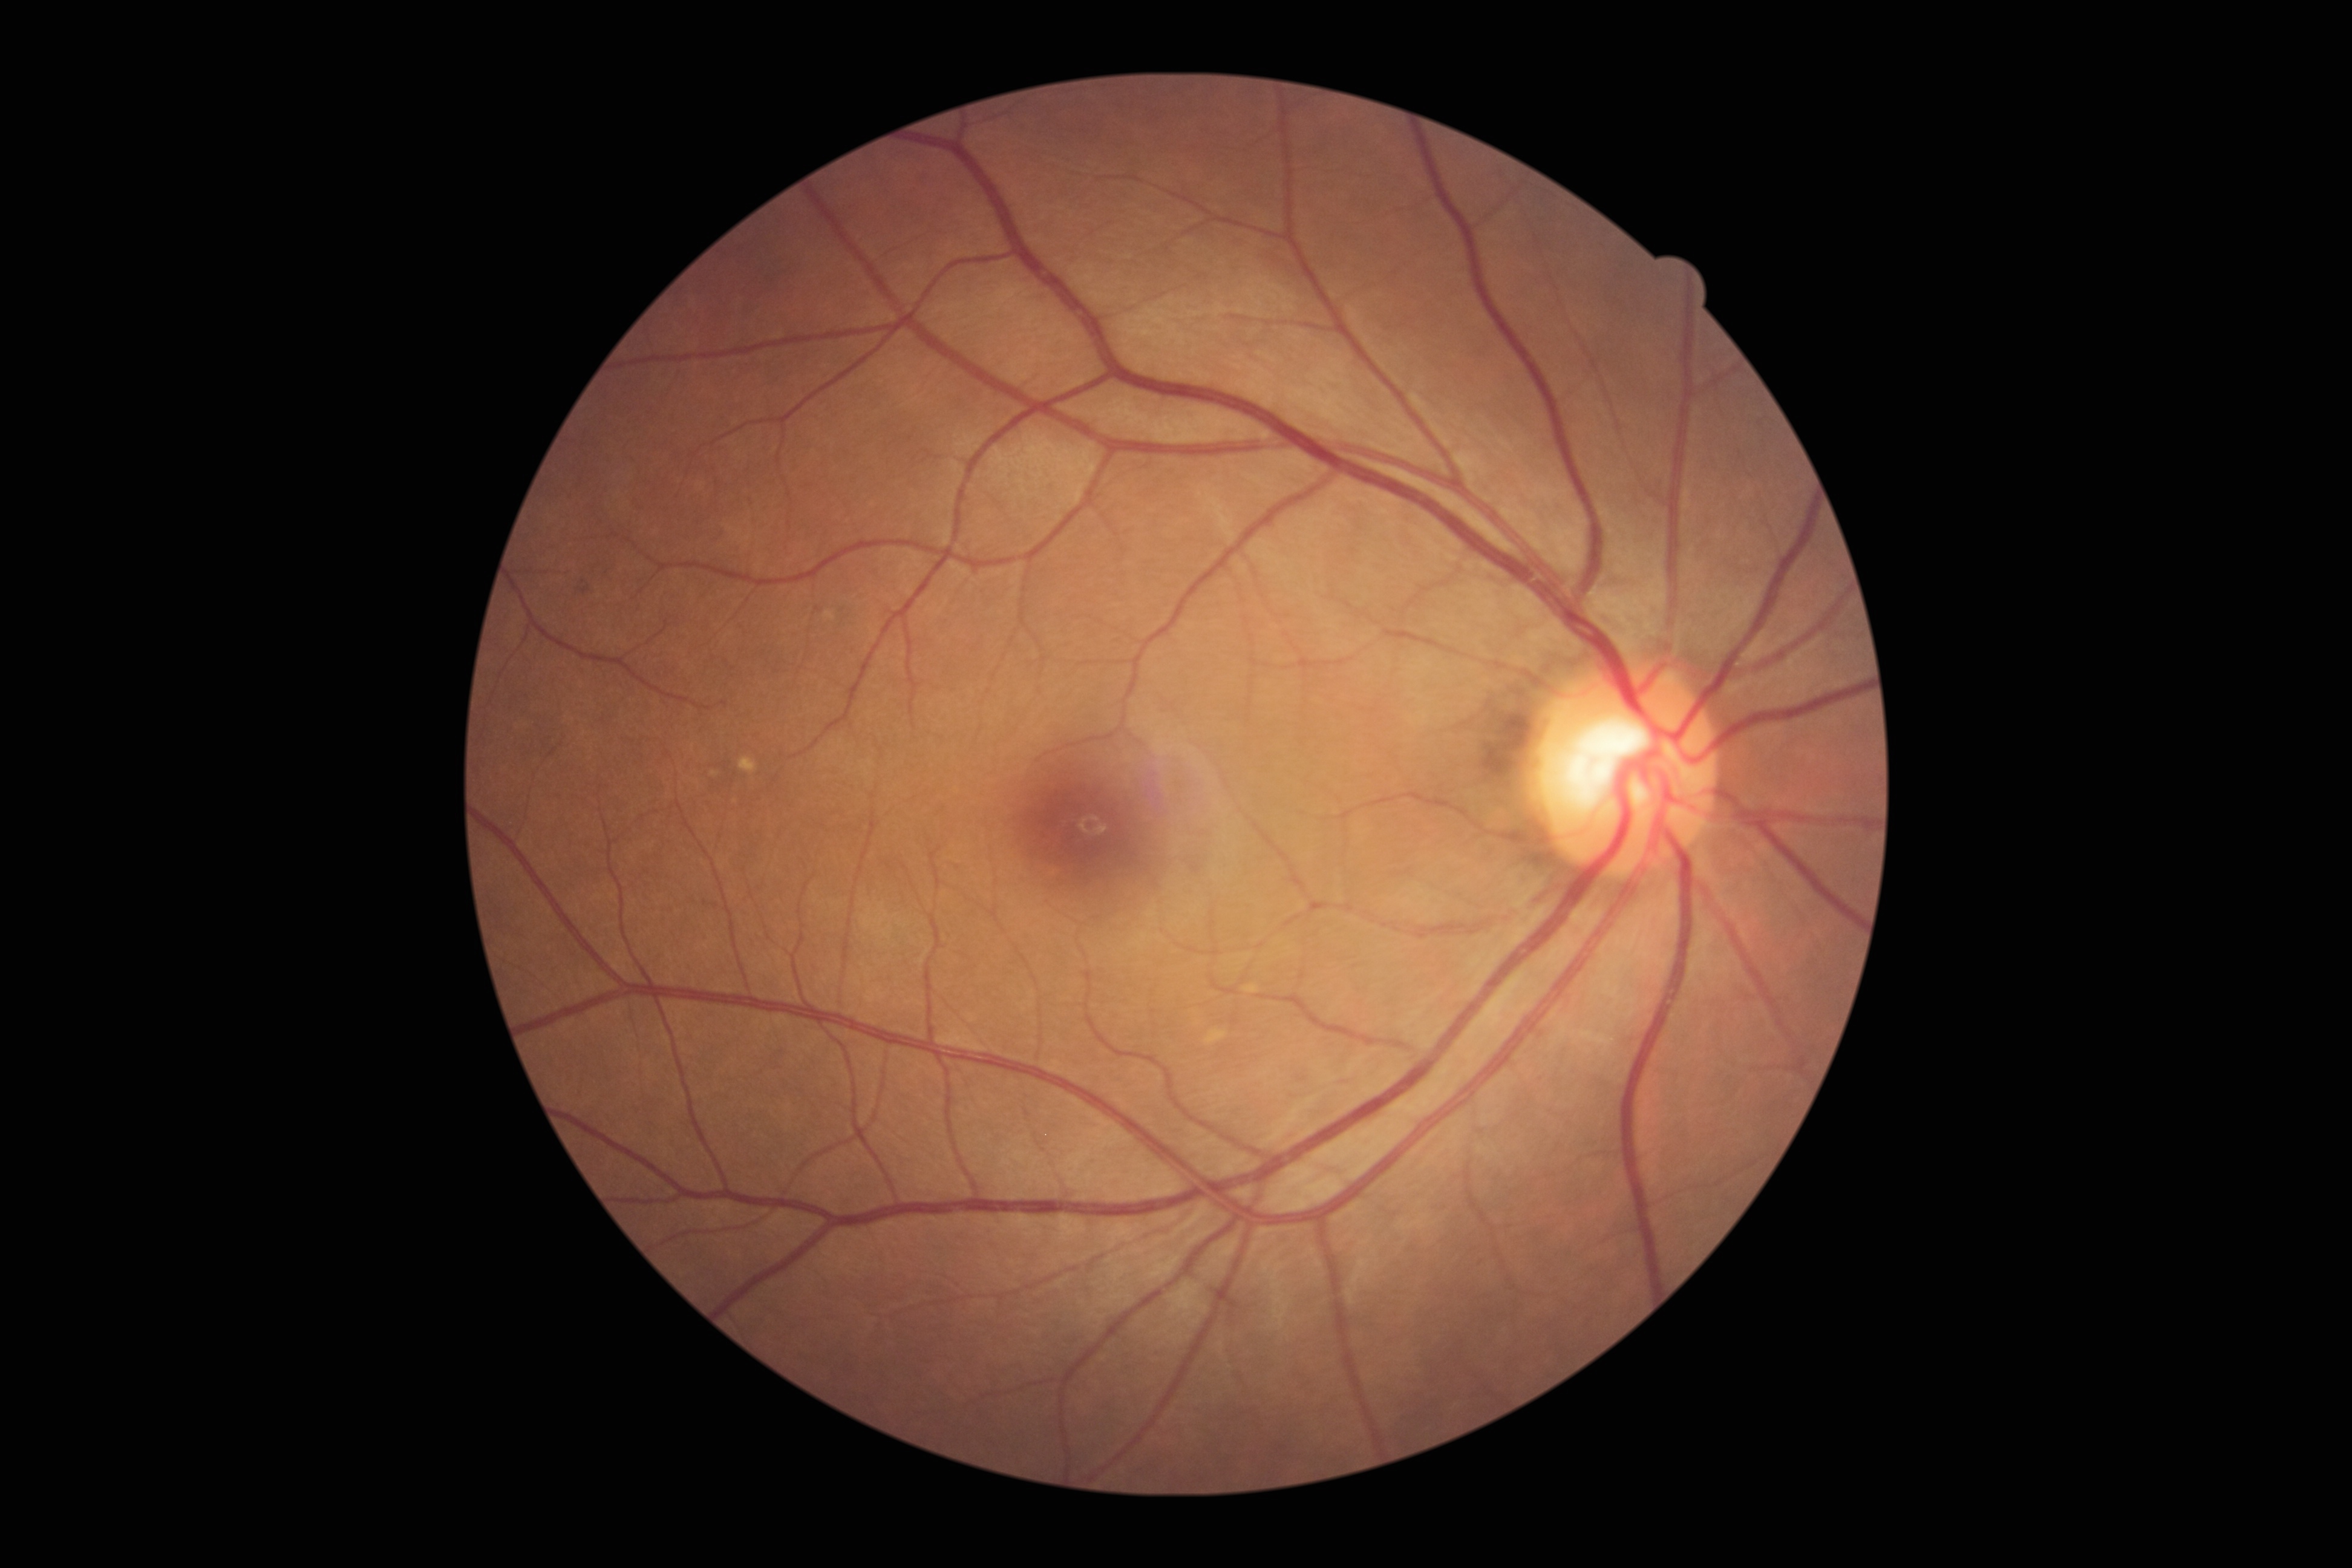
Diabetic retinopathy (DR): grade 0 (no apparent retinopathy).